Color fundus image; 50° FOV; dilated-pupil acquisition; central posterior field; 2228 by 1652 pixels; acquired with a Topcon TRC-50DX: 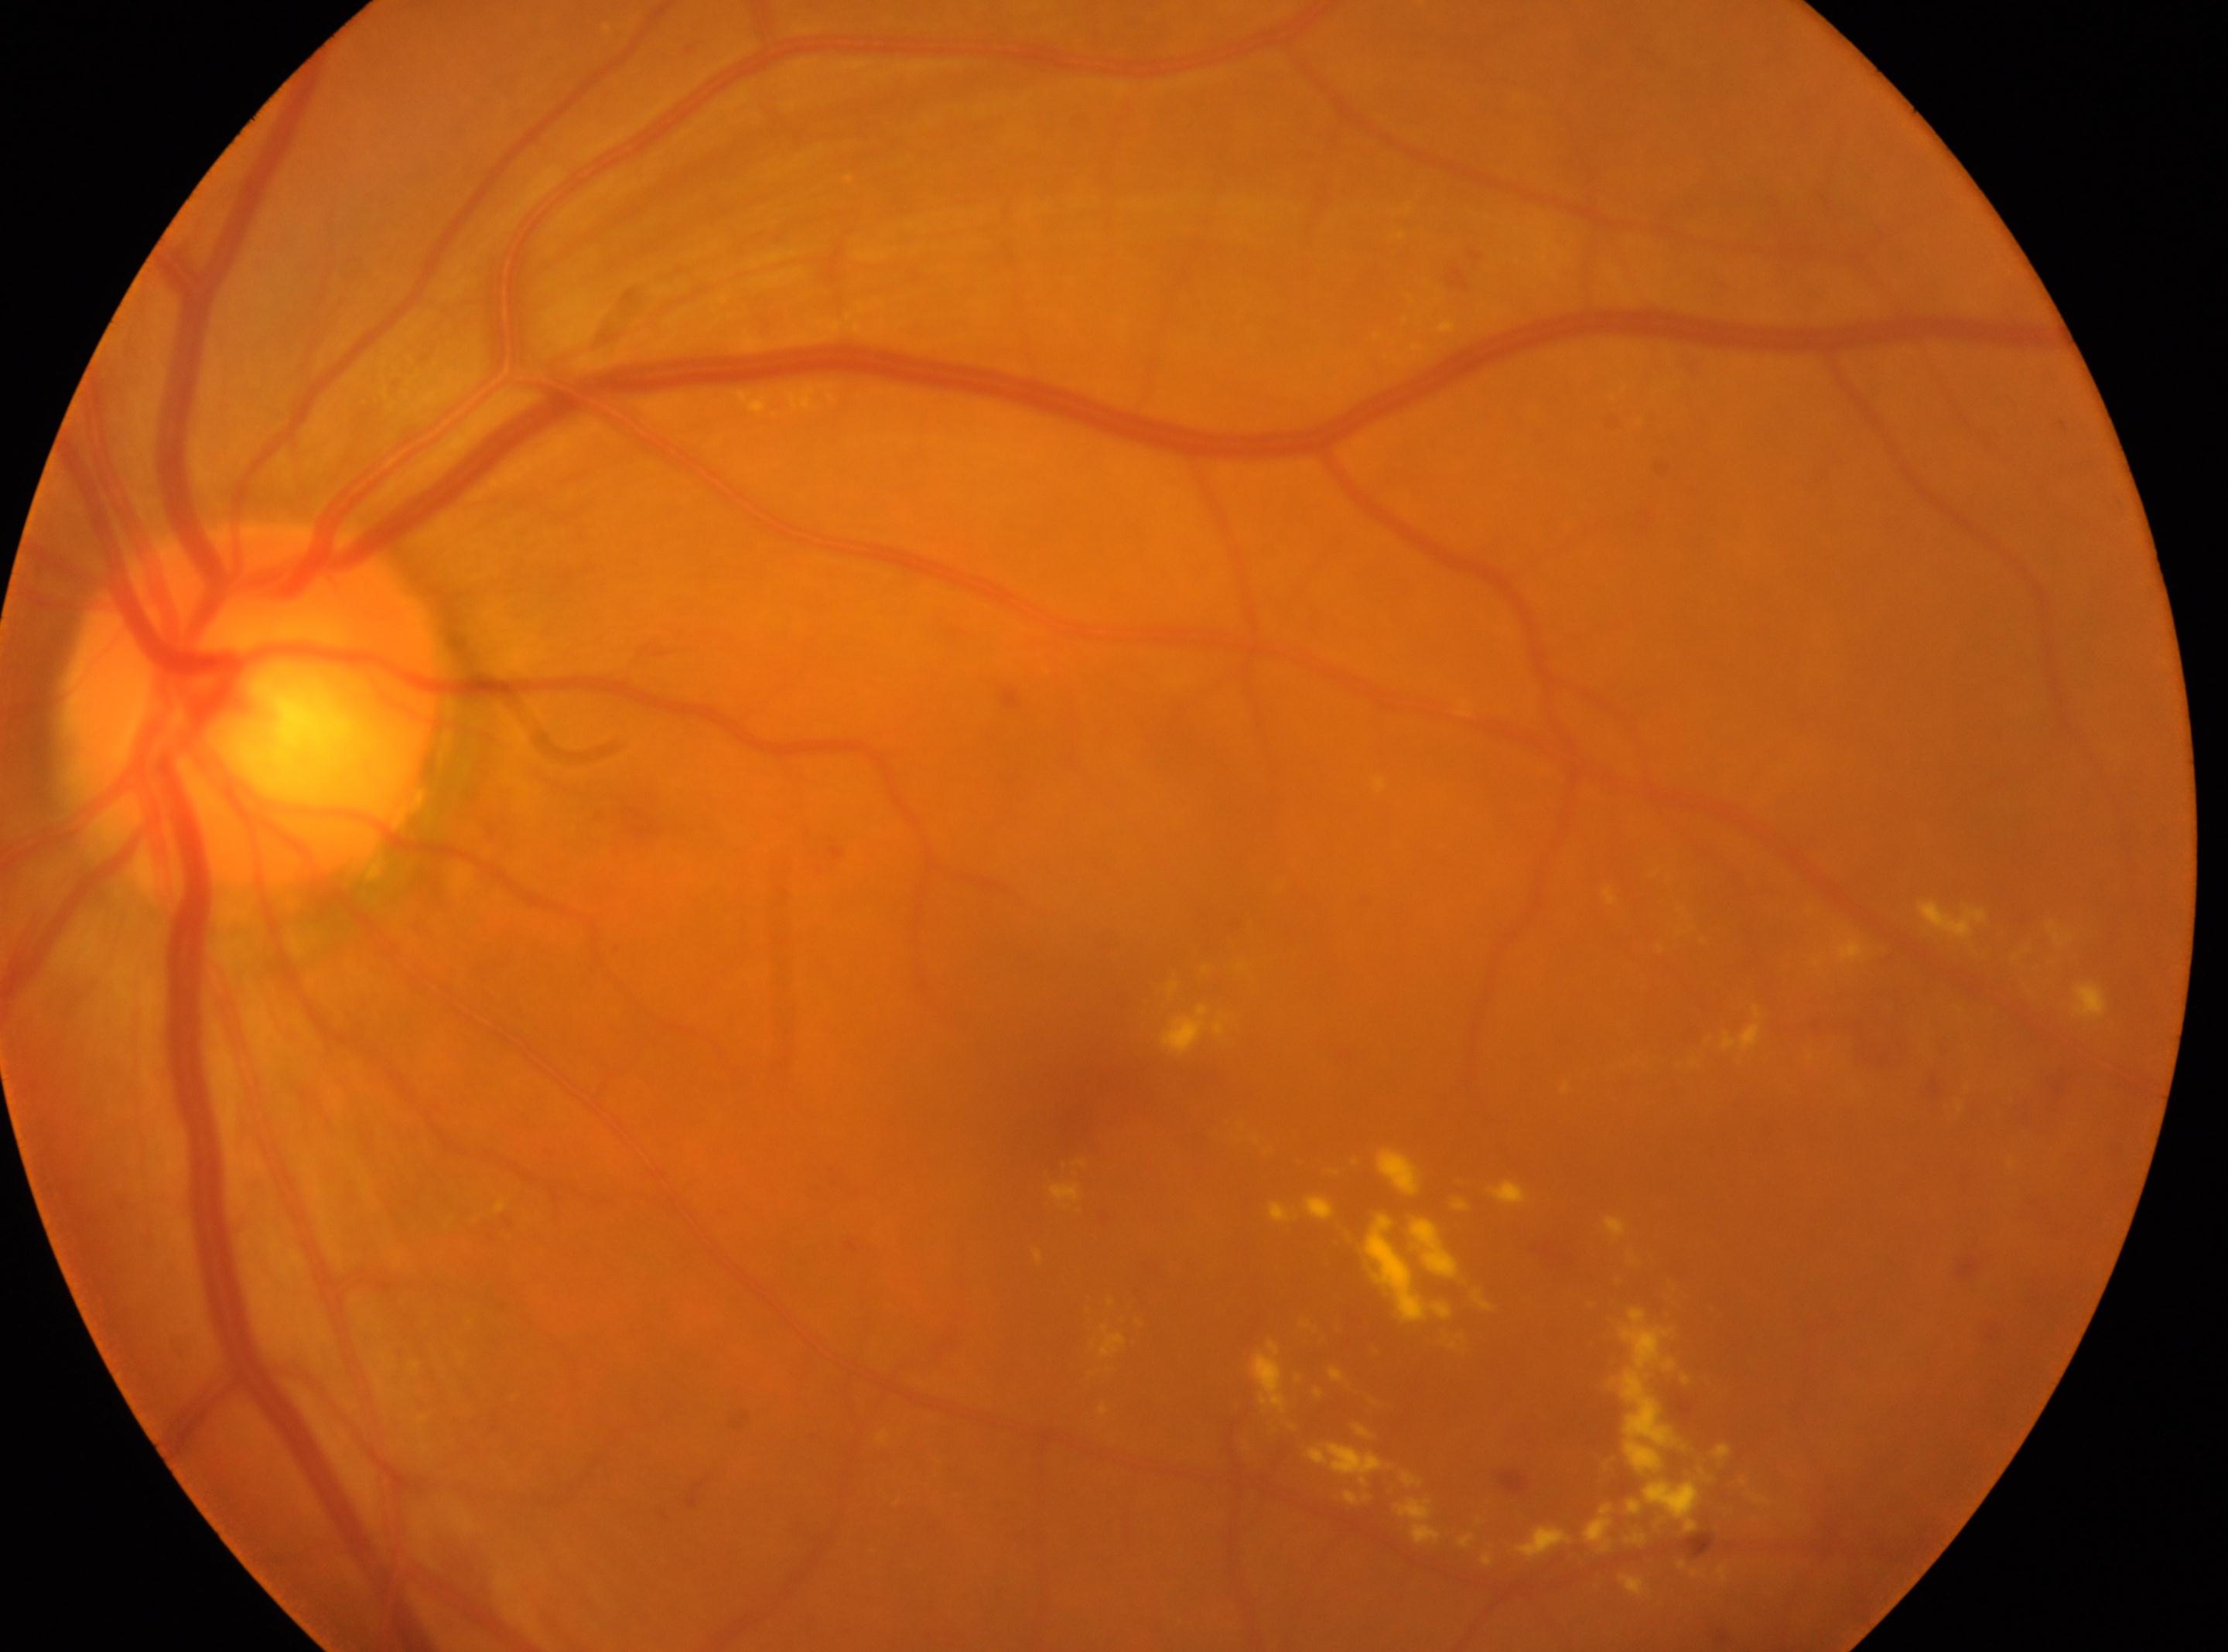 retinopathy = grade 2; foveal center = 1072px, 1097px; optic disc = 252px, 710px; laterality = left.